Ultra-widefield fundus mosaic; FOV: 200 degrees.
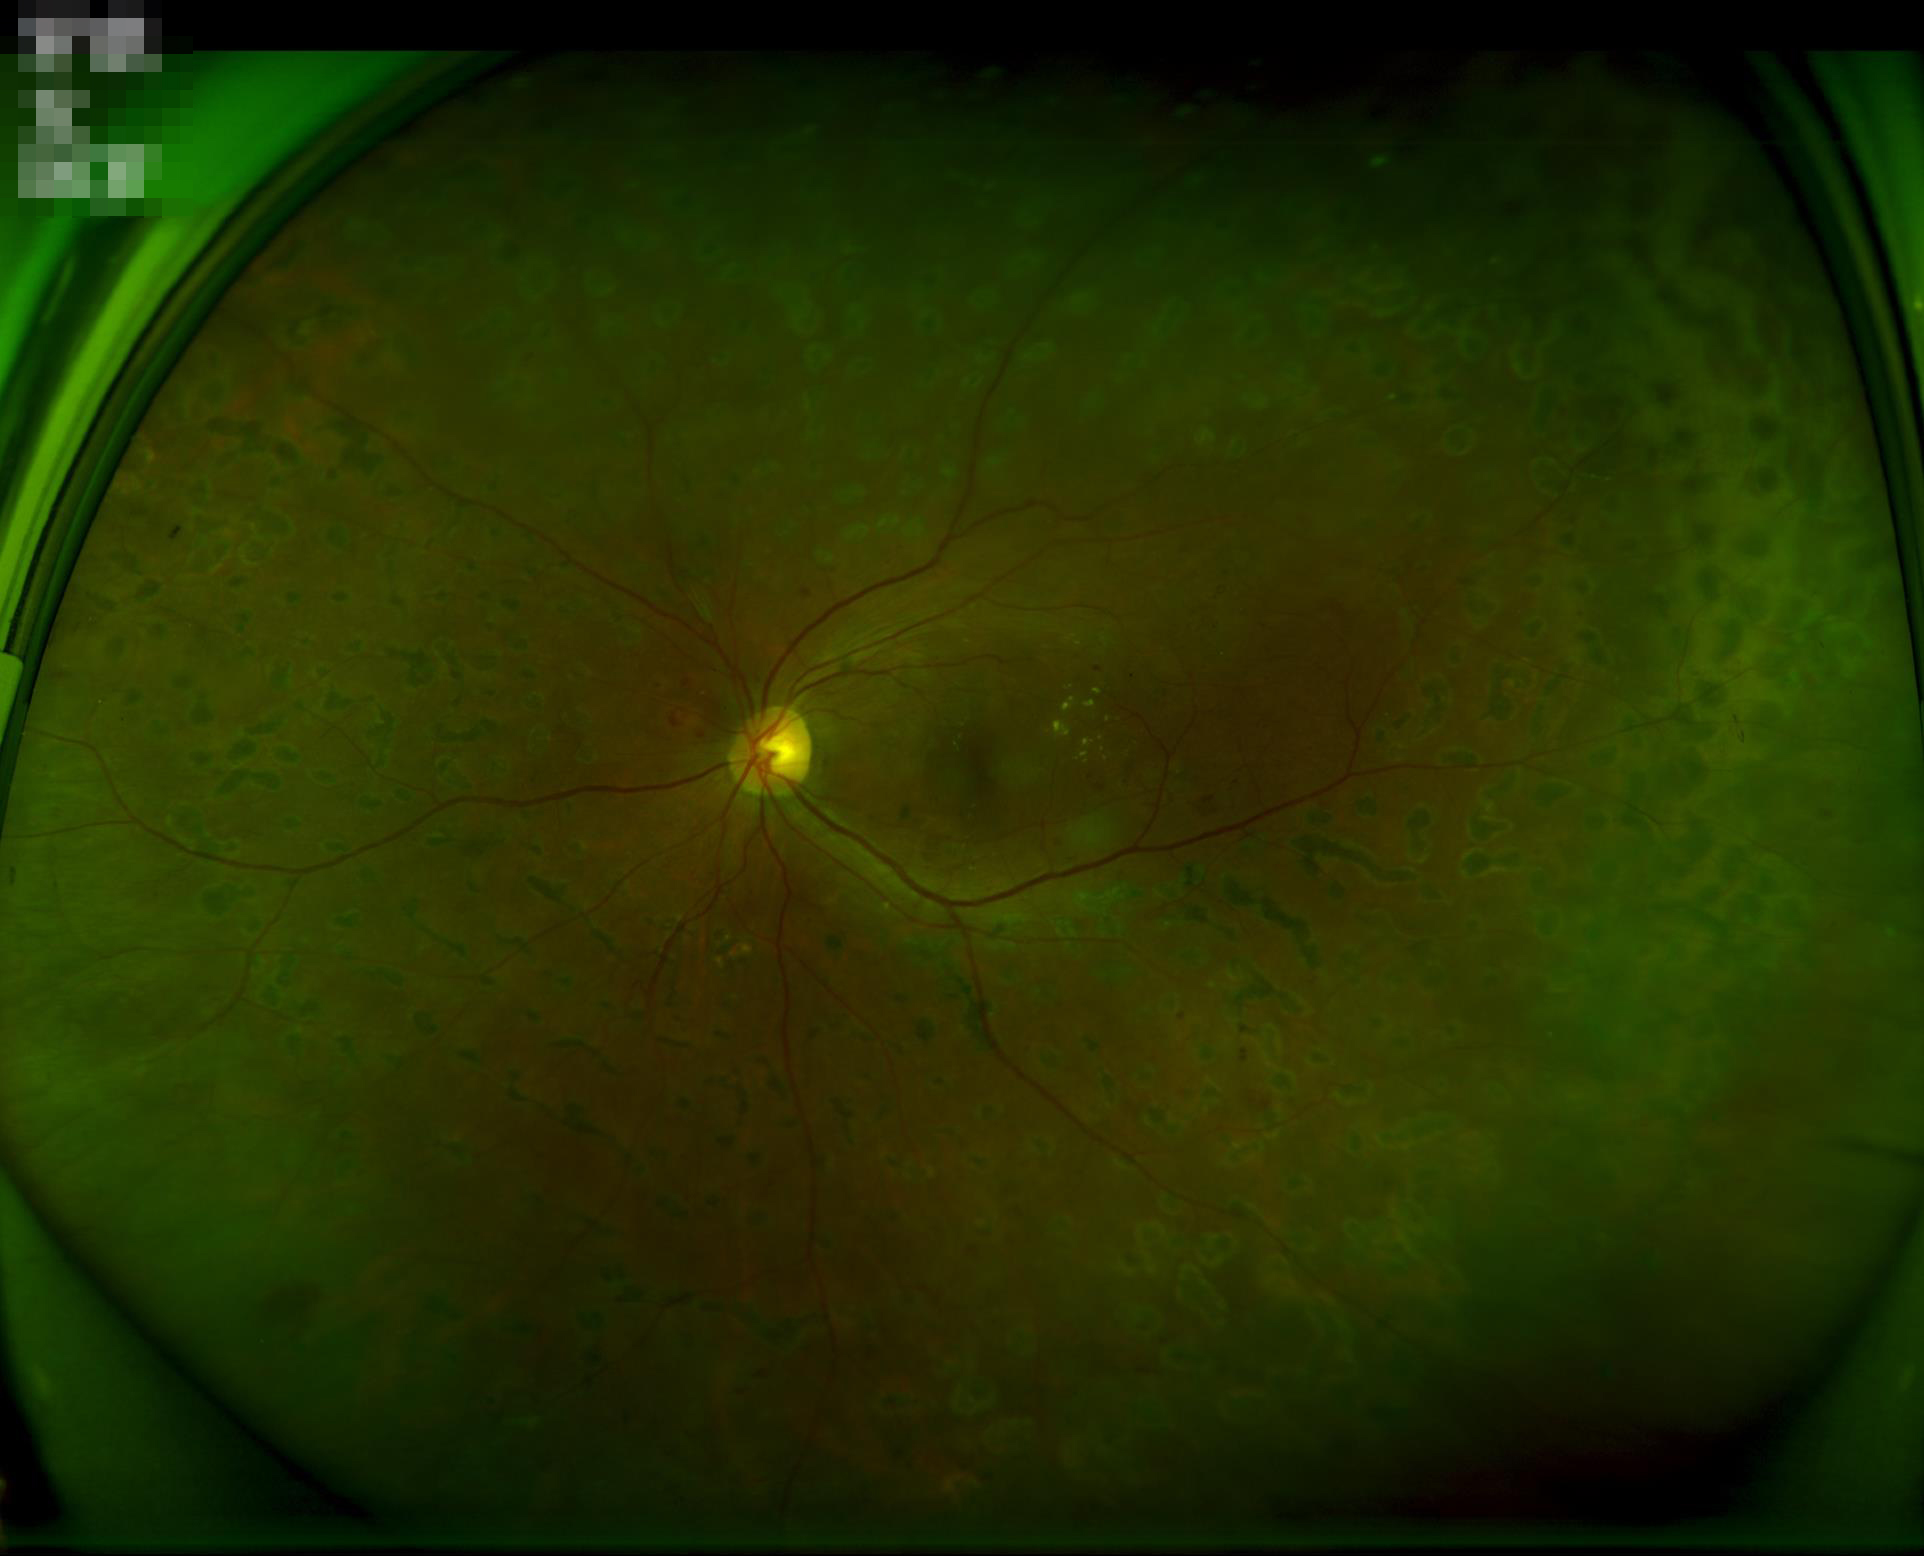 No over- or under-exposure. Contrast is good. Image is sharp throughout the field.